Fundus photo: 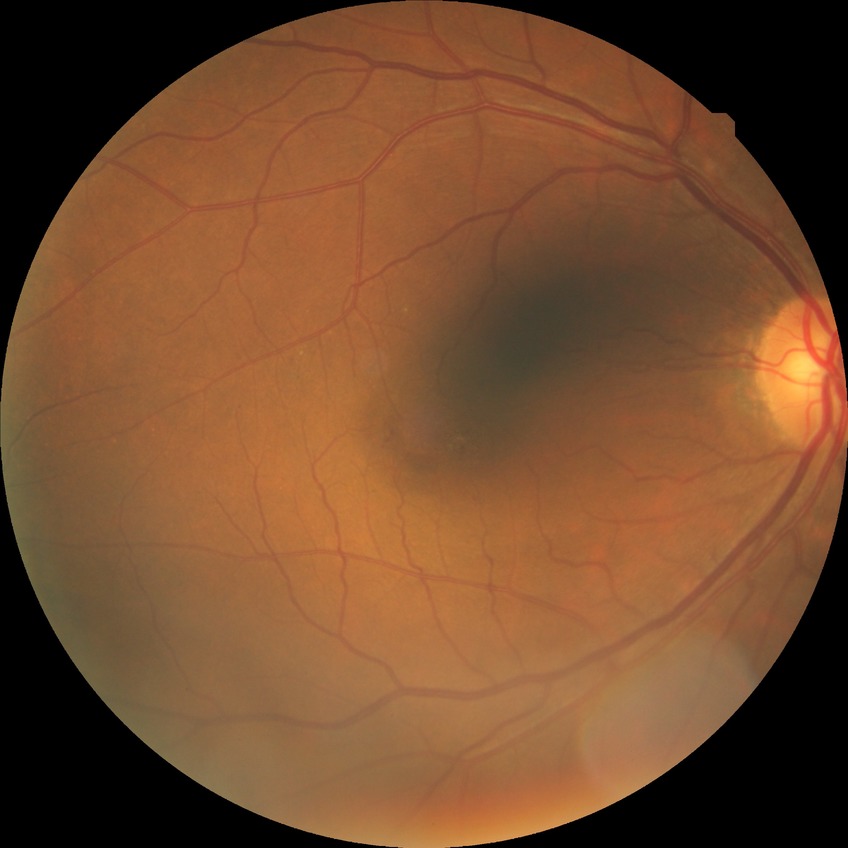

Modified Davis grading is no diabetic retinopathy.